2048 x 1536 pixels
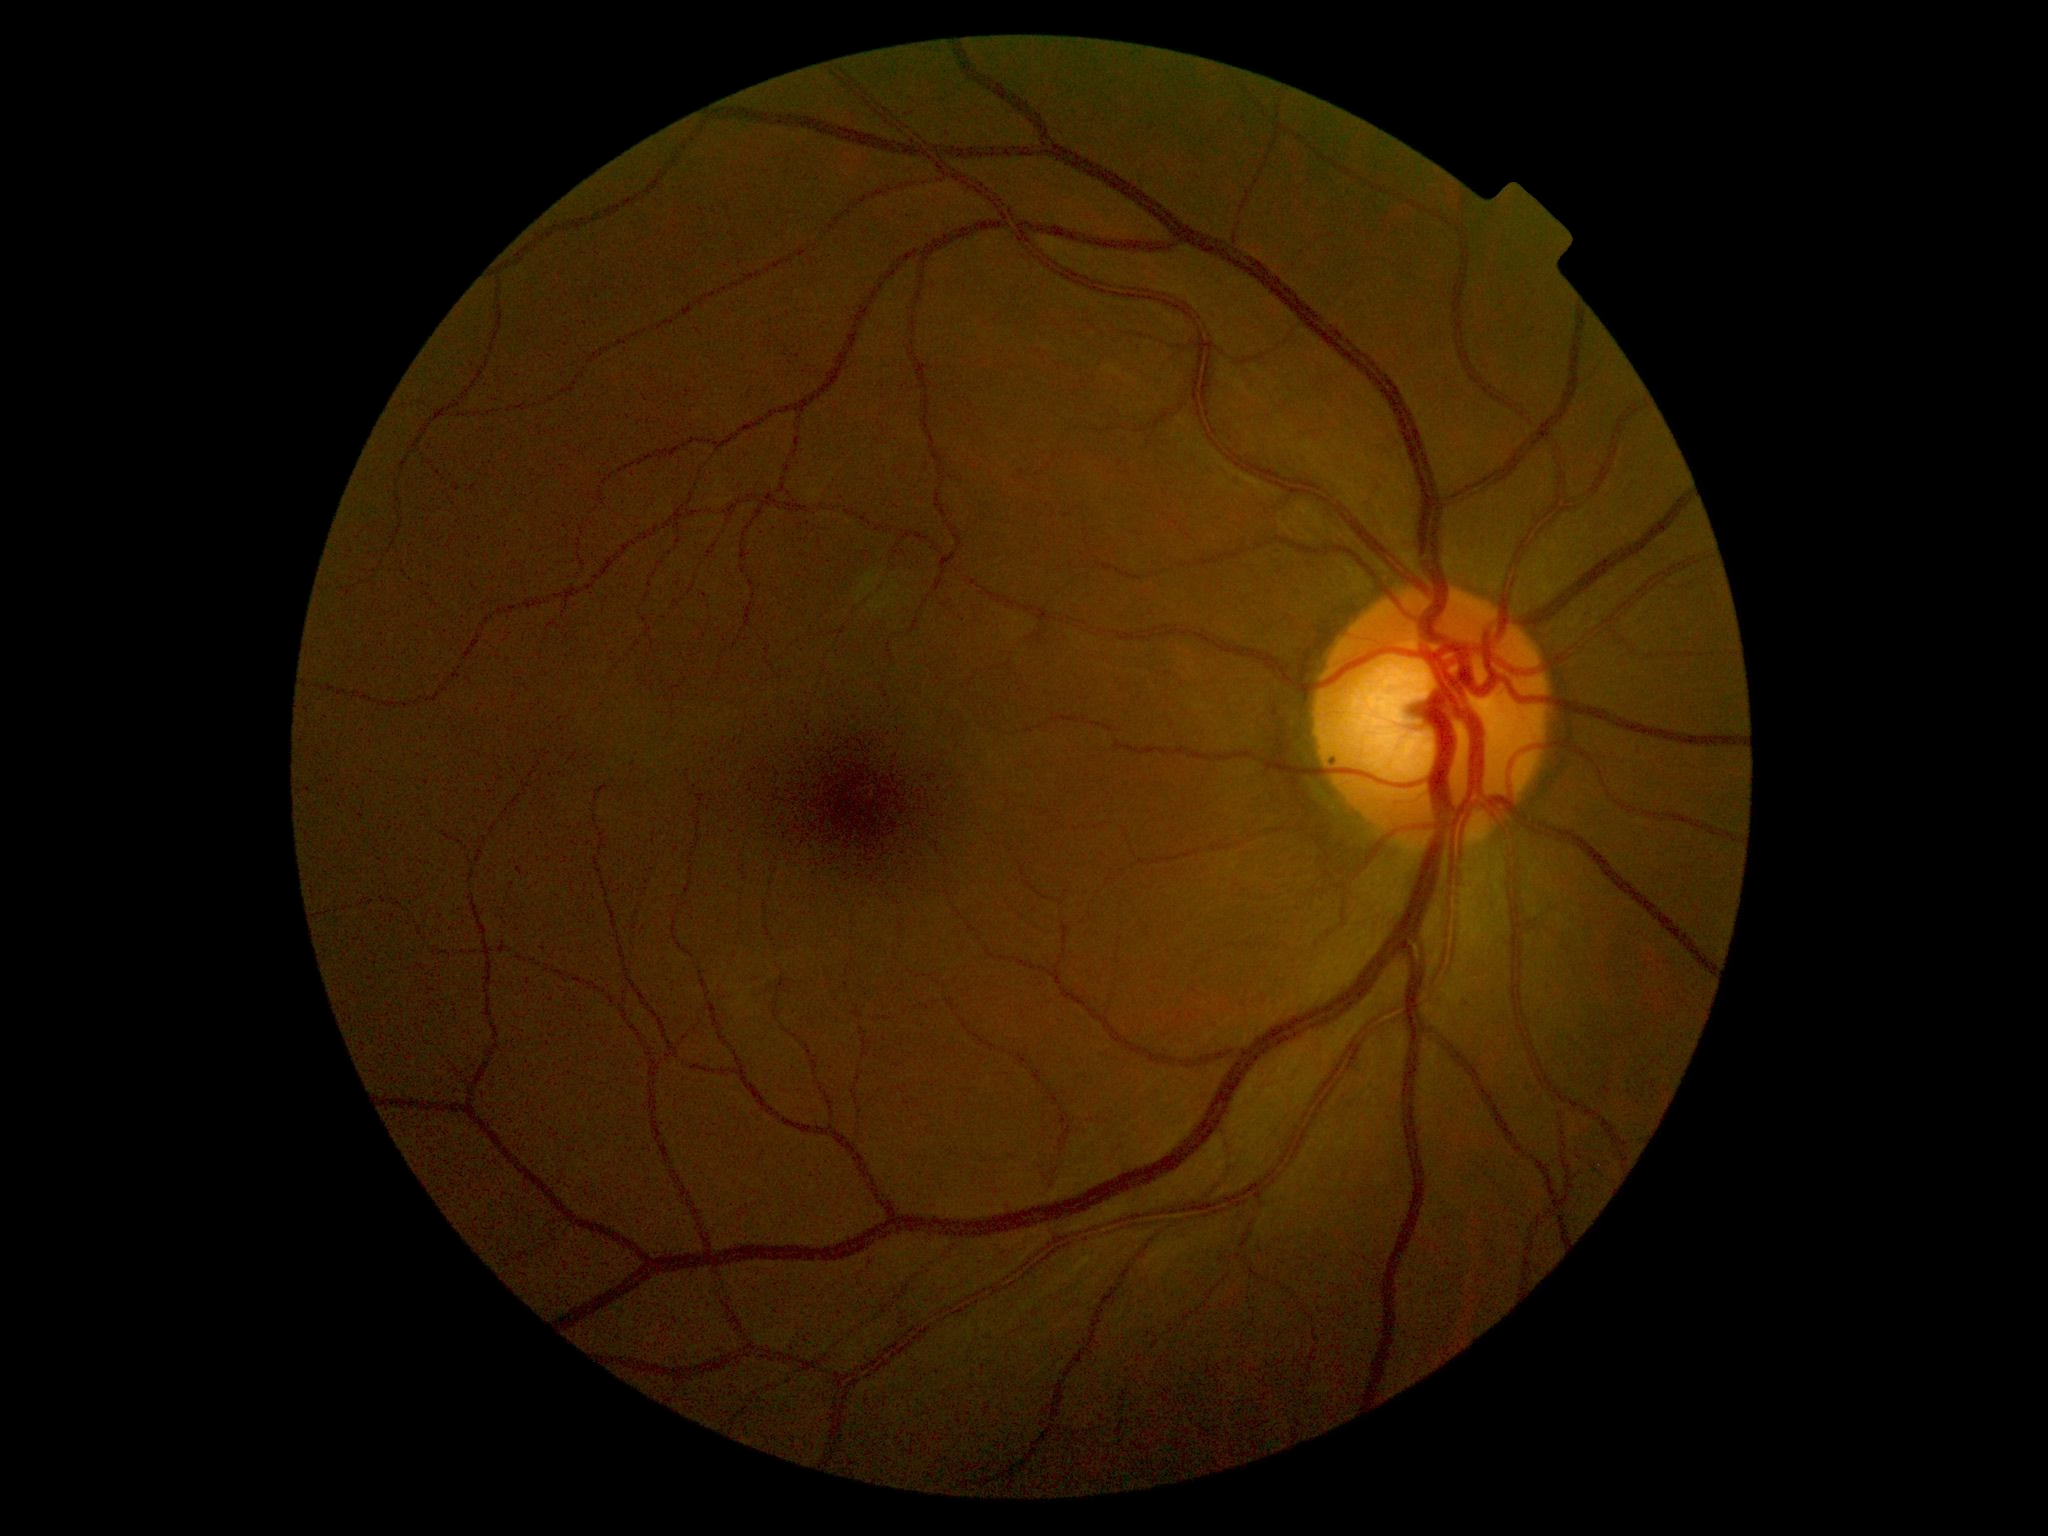

Diabetic retinopathy grade: 0.